Color fundus photograph — 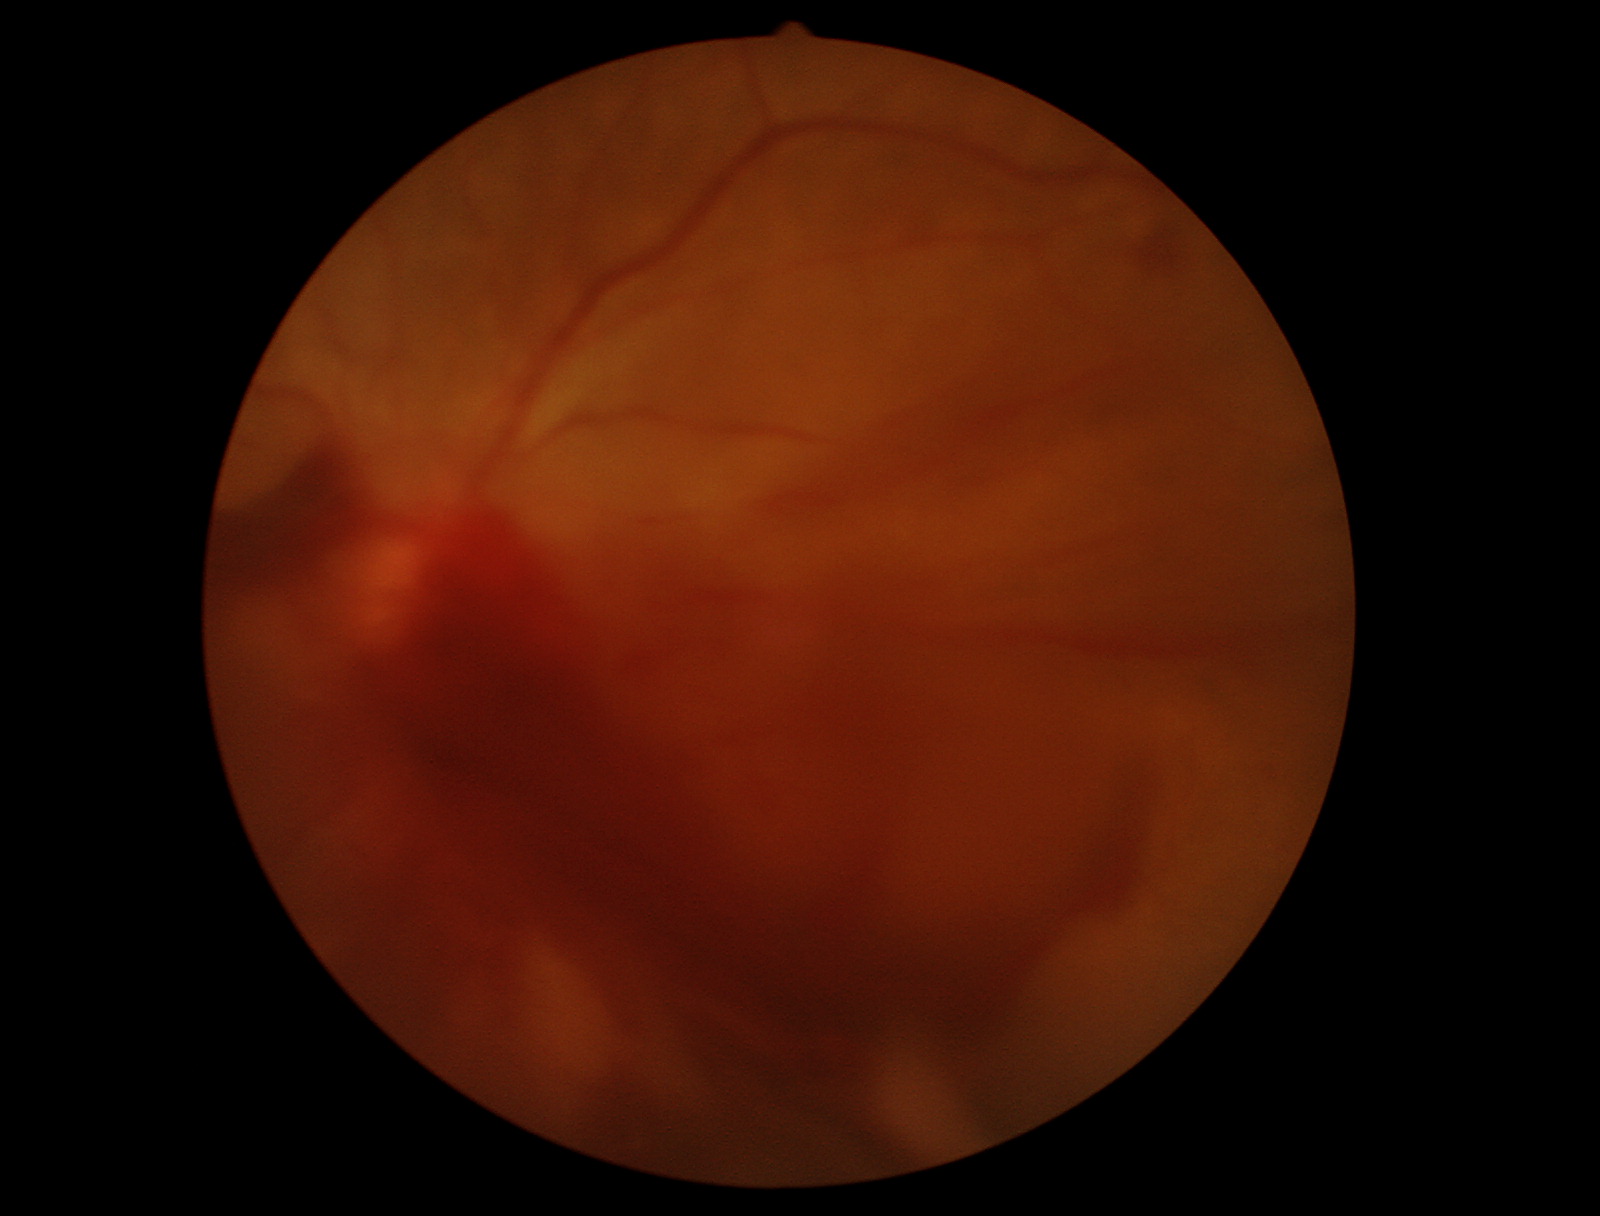
Gradability: poor, substantial obscuration of retinal landmarks. Proliferative diabetic retinopathy: features suspicious.